Cropped to the optic nerve head. 240 x 240 pixels. Non-mydriatic acquisition
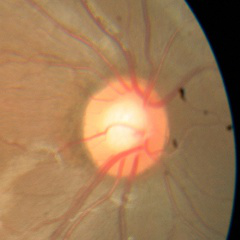

Q: Glaucoma assessment?
A: No glaucoma.